45° field of view. 2048 by 1536 pixels. Color fundus image
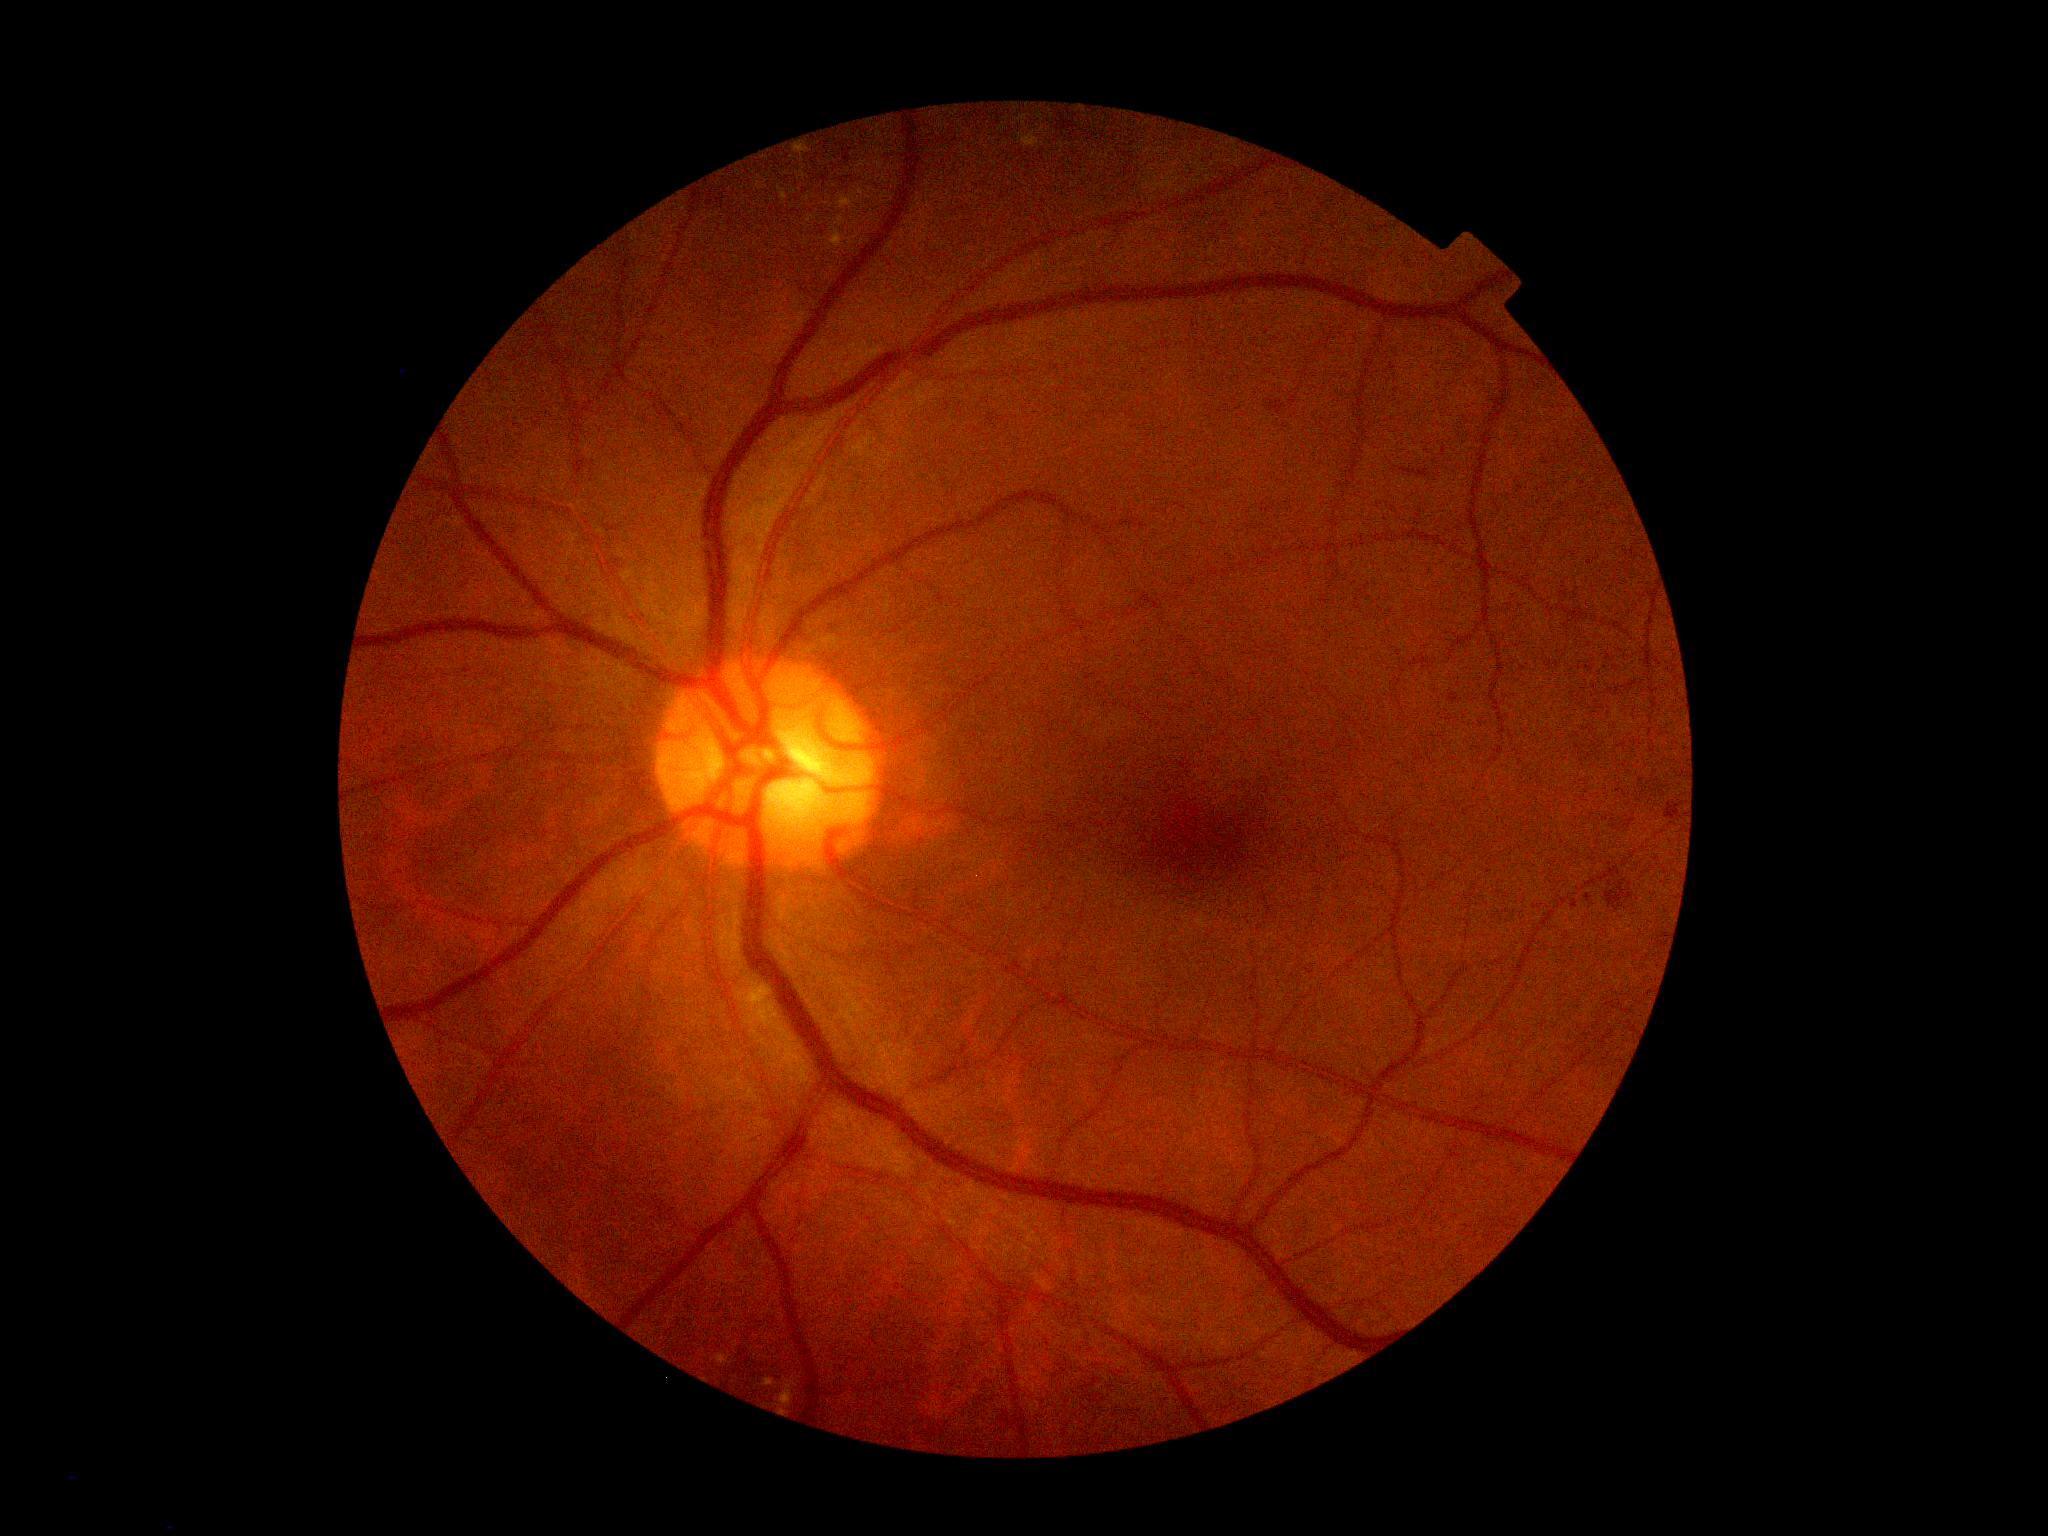

diabetic retinopathy (DR): moderate non-proliferative diabetic retinopathy (grade 2).